Modified Davis classification.
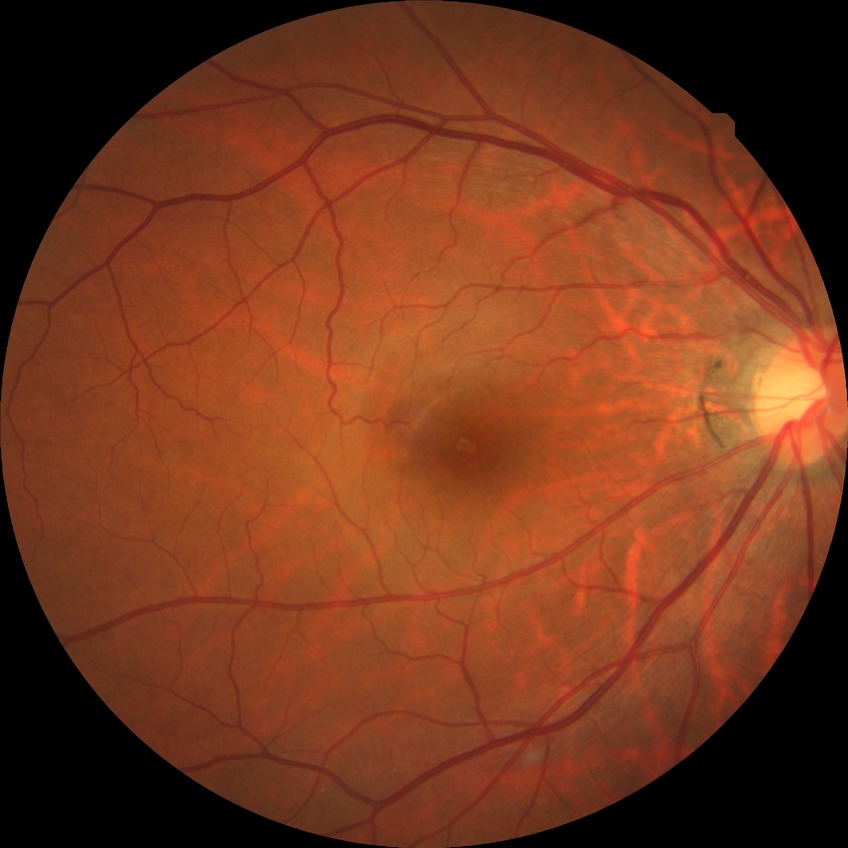
Diabetic retinopathy (DR): NDR (no diabetic retinopathy).